45-degree field of view.
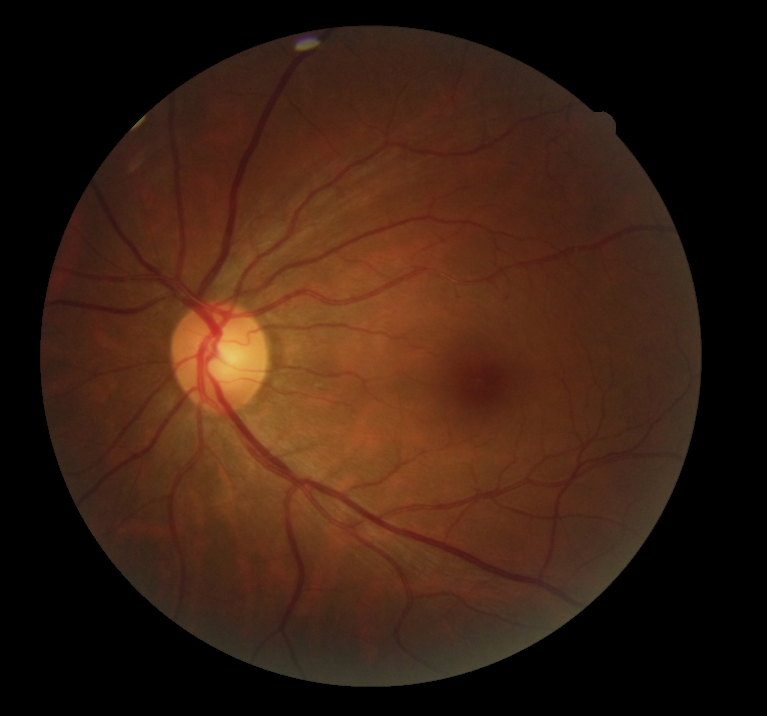
  dr_grade: 0